Infant wide-field retinal image:
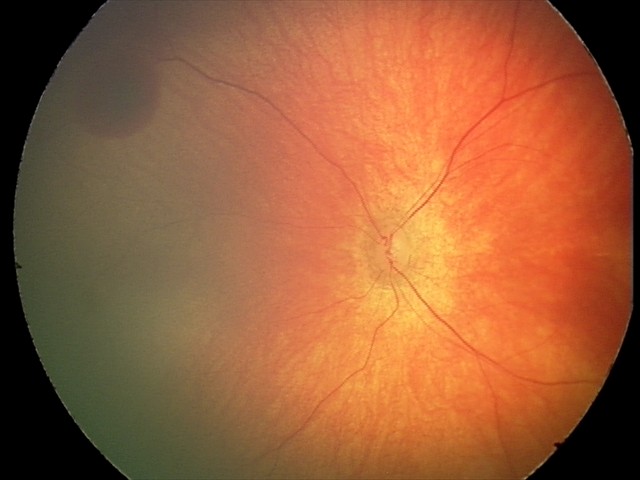 Series diagnosed as retinal hemorrhages.